Pediatric wide-field fundus photograph · 1240x1240px:
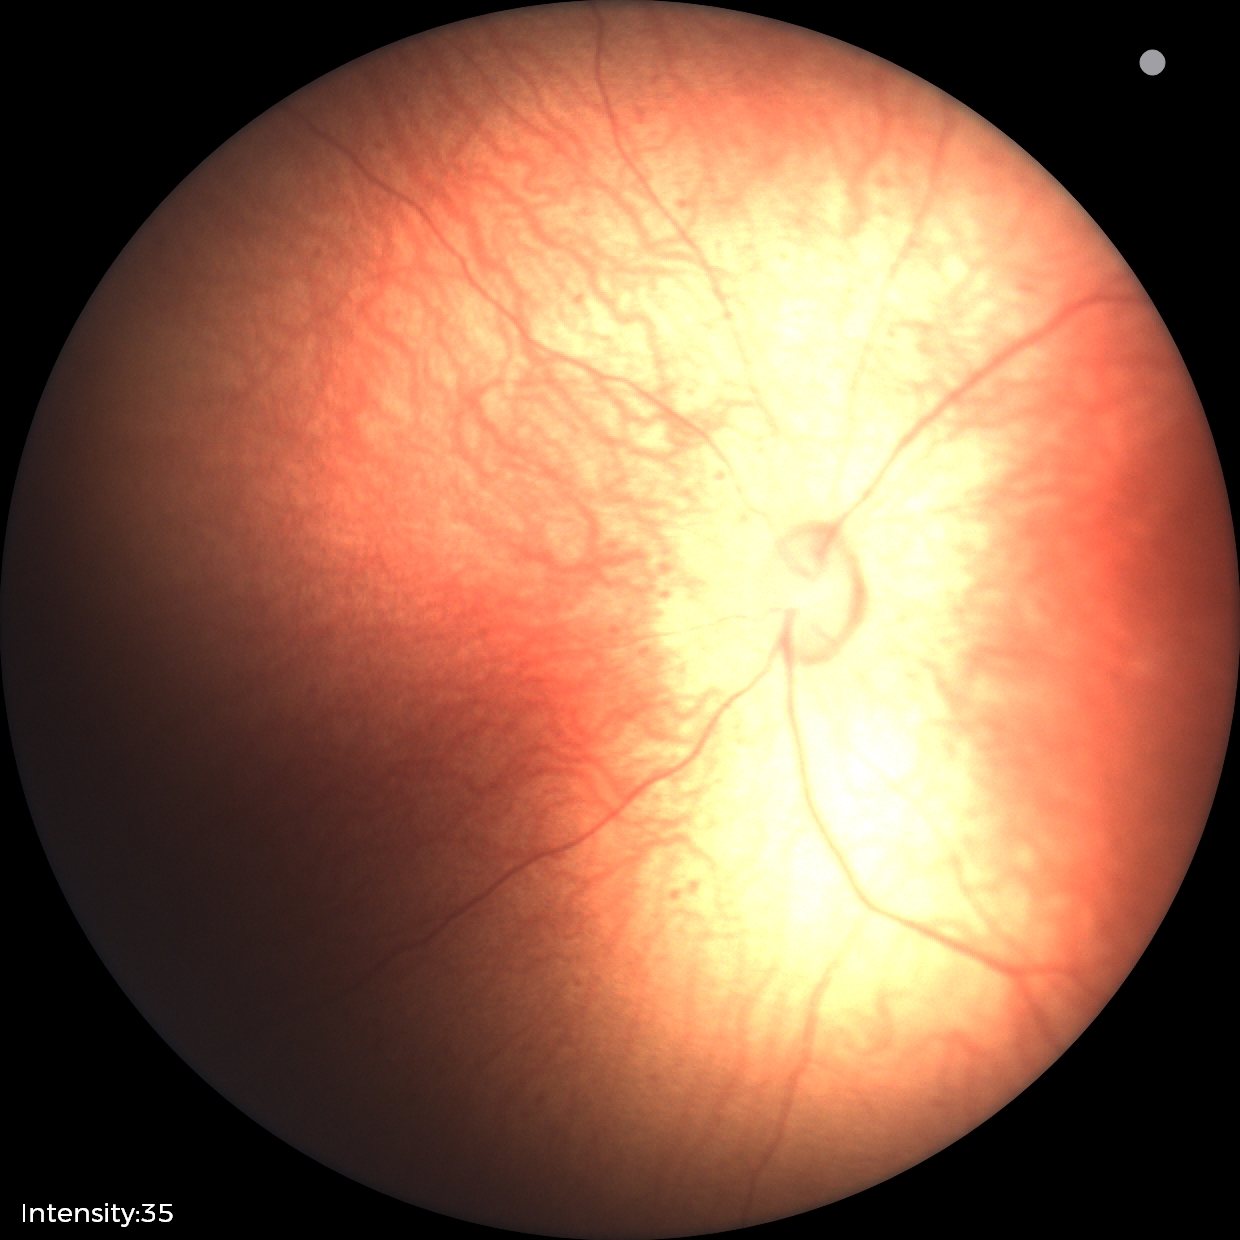
Screening examination consistent with retinopathy of prematurity (ROP) stage 1. Plus disease absent.